Wide-field fundus image from infant ROP screening:
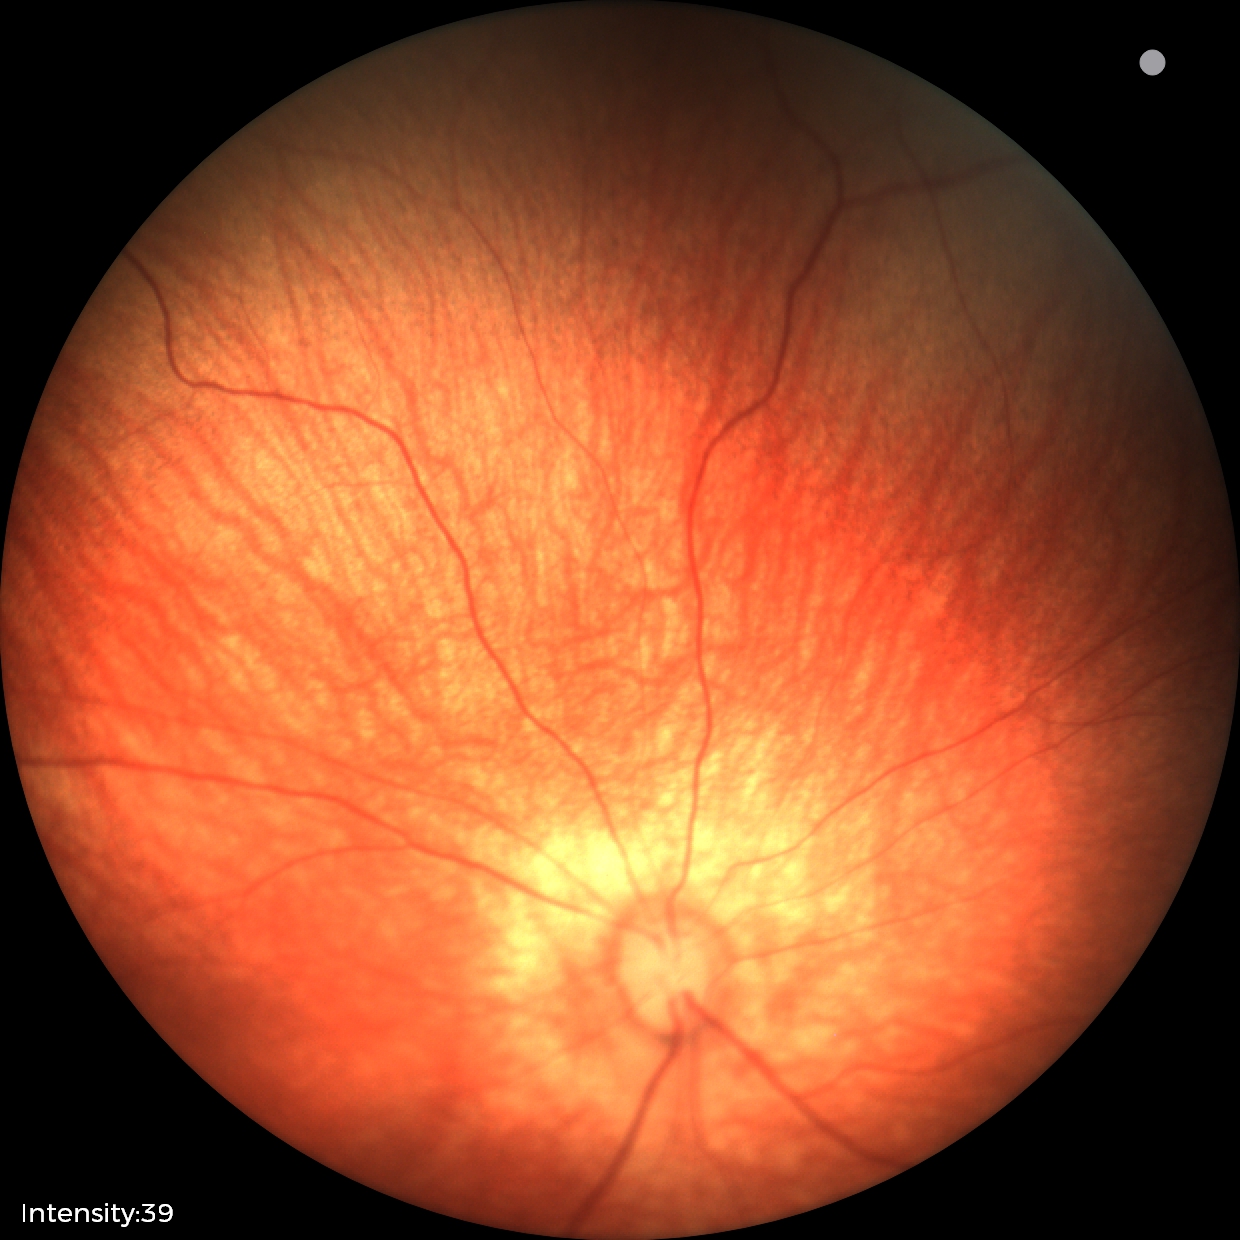

Impression = physiological.